640 by 480 pixels · wide-field contact fundus photograph of an infant.
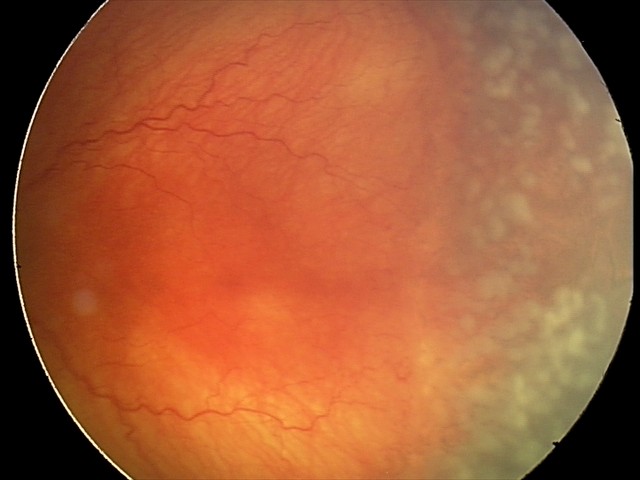 Series diagnosed as aggressive ROP (A-ROP).